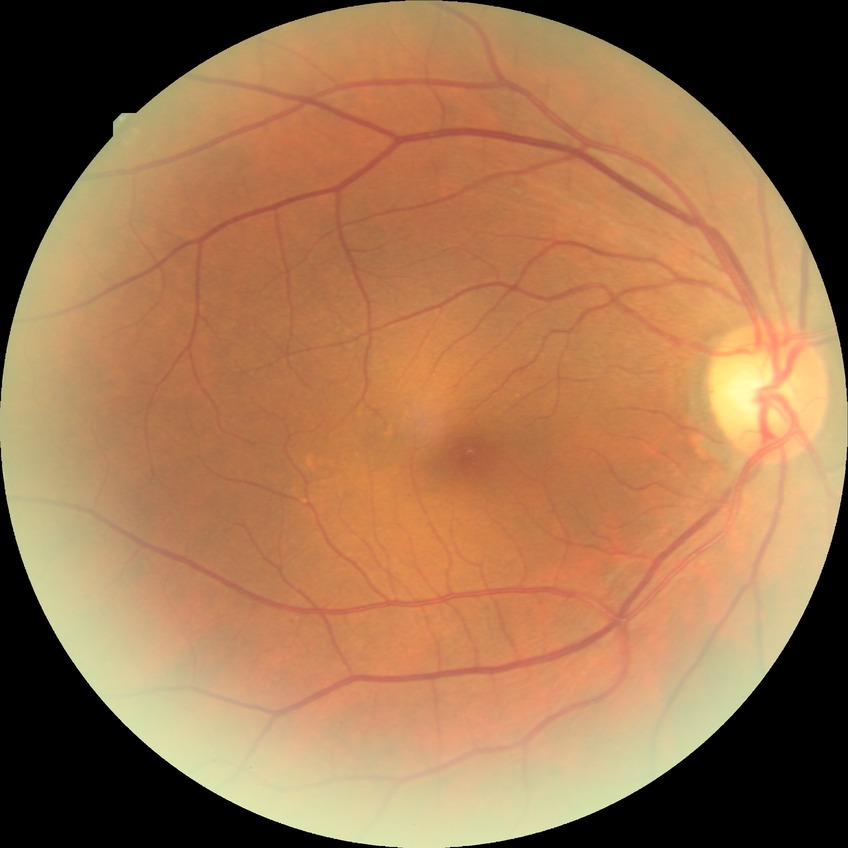

Diabetic retinopathy (DR): no diabetic retinopathy (NDR).